Infant wide-field fundus photograph. Camera: Natus RetCam Envision (130° FOV): 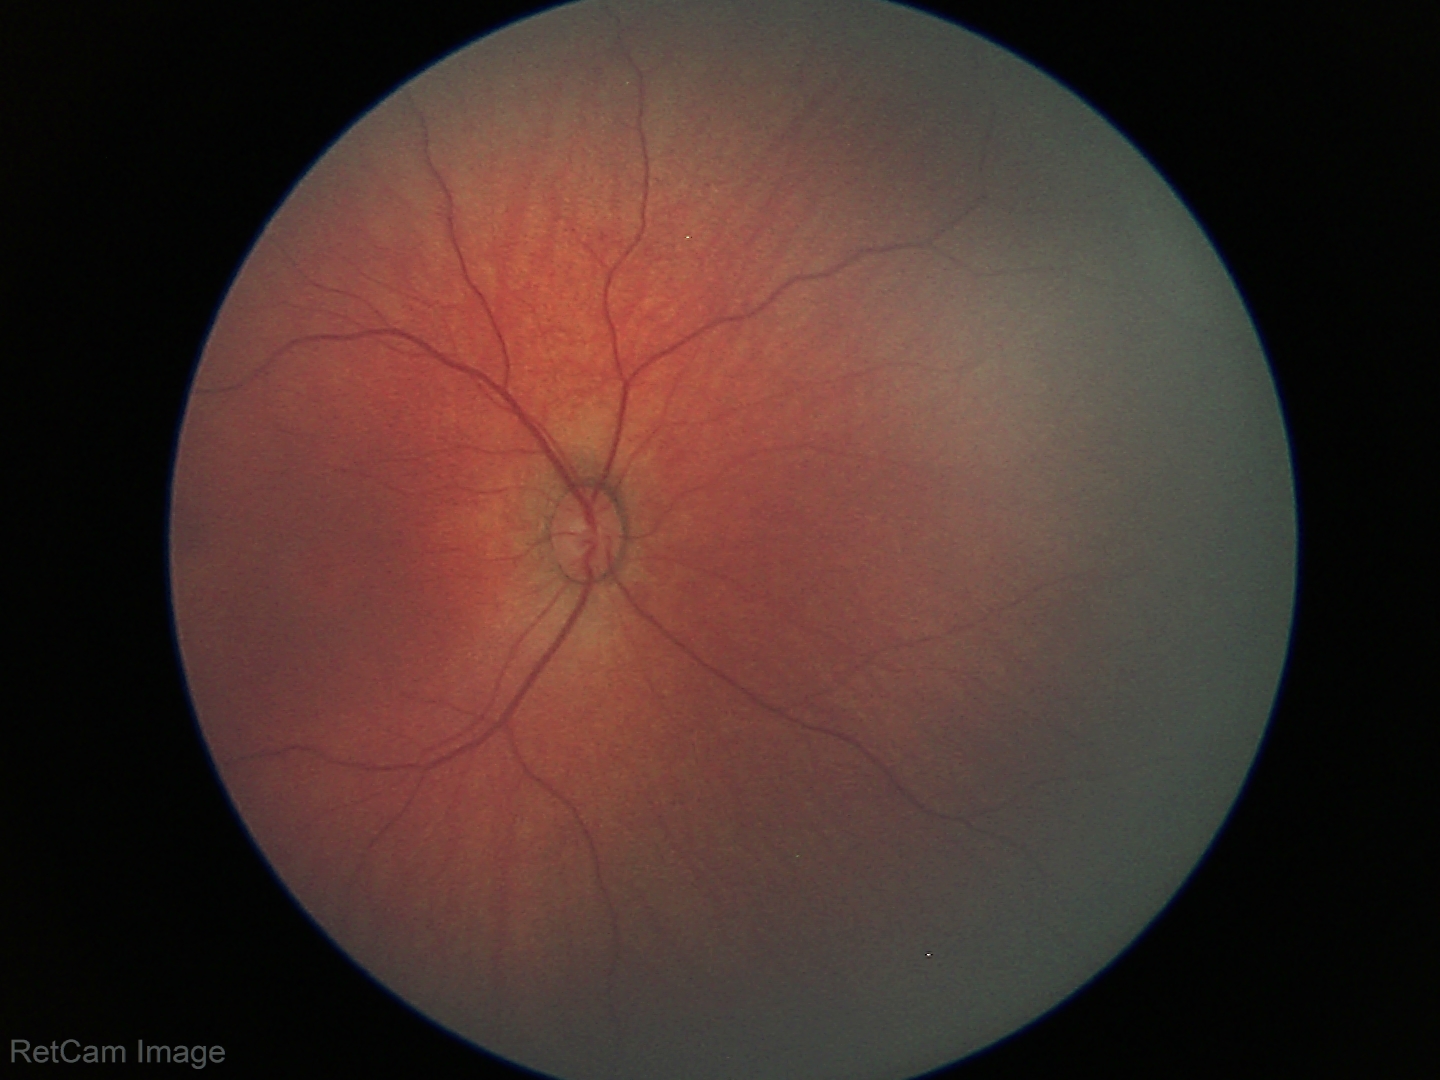
Screening examination with no abnormal retinal findings.